45 degree fundus photograph: 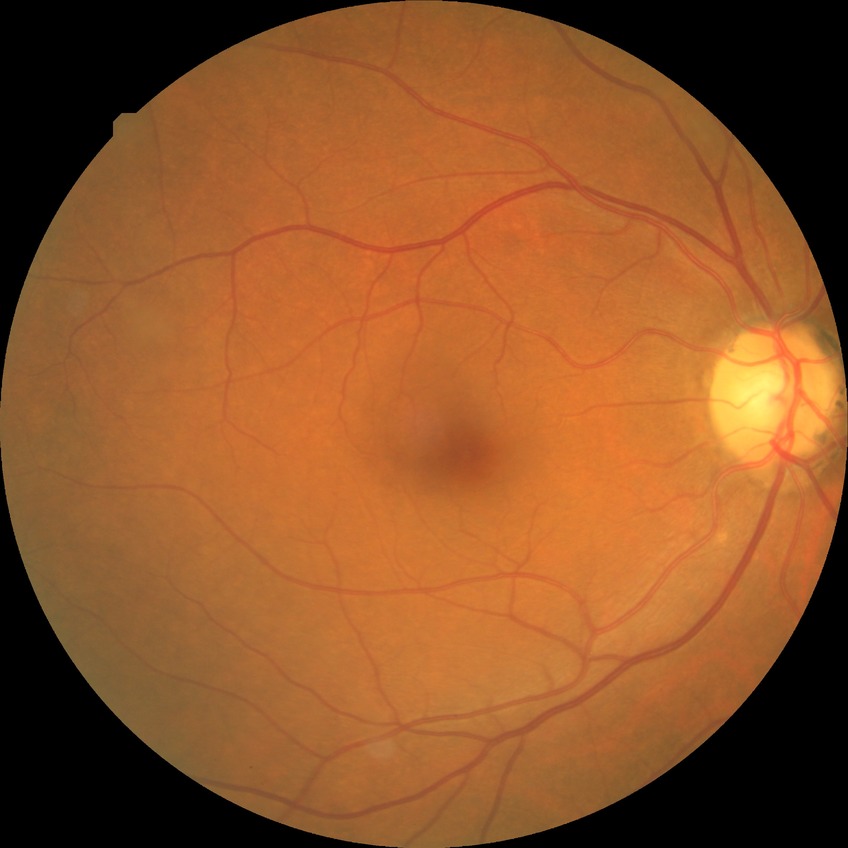 davis_grade: NDR